Optic disc region of a color fundus photo
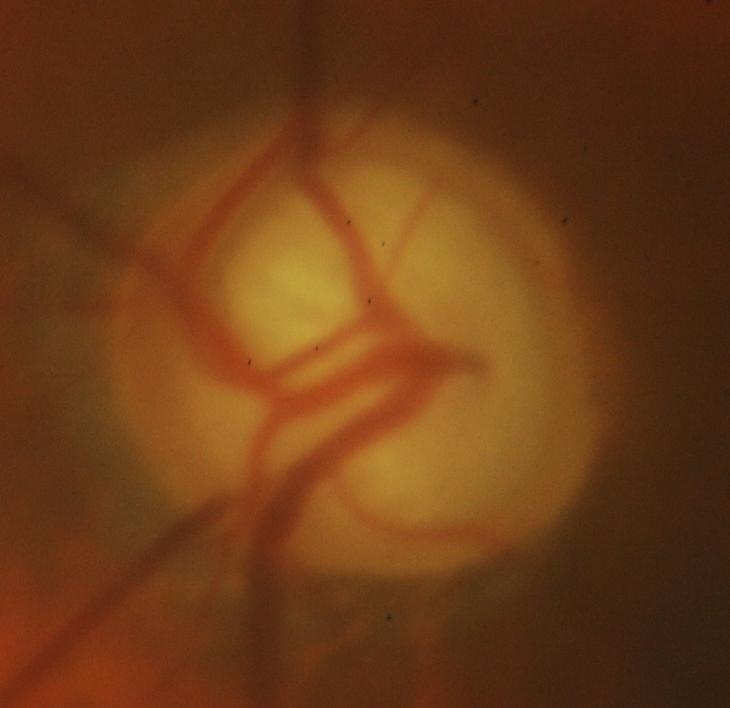

Q: What is the glaucoma diagnosis?
A: Yes — glaucomatous findings.